Modified Davis grading. 848x848. Nonmydriatic. NIDEK AFC-230. 45-degree field of view:
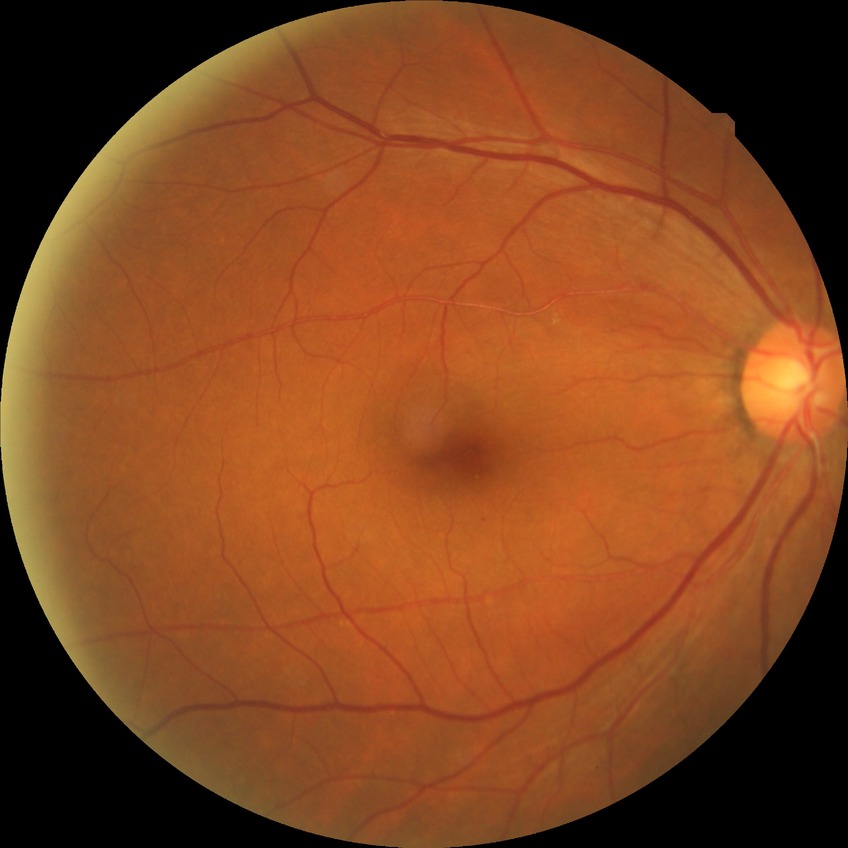
Diabetic retinopathy grade: simple diabetic retinopathy.